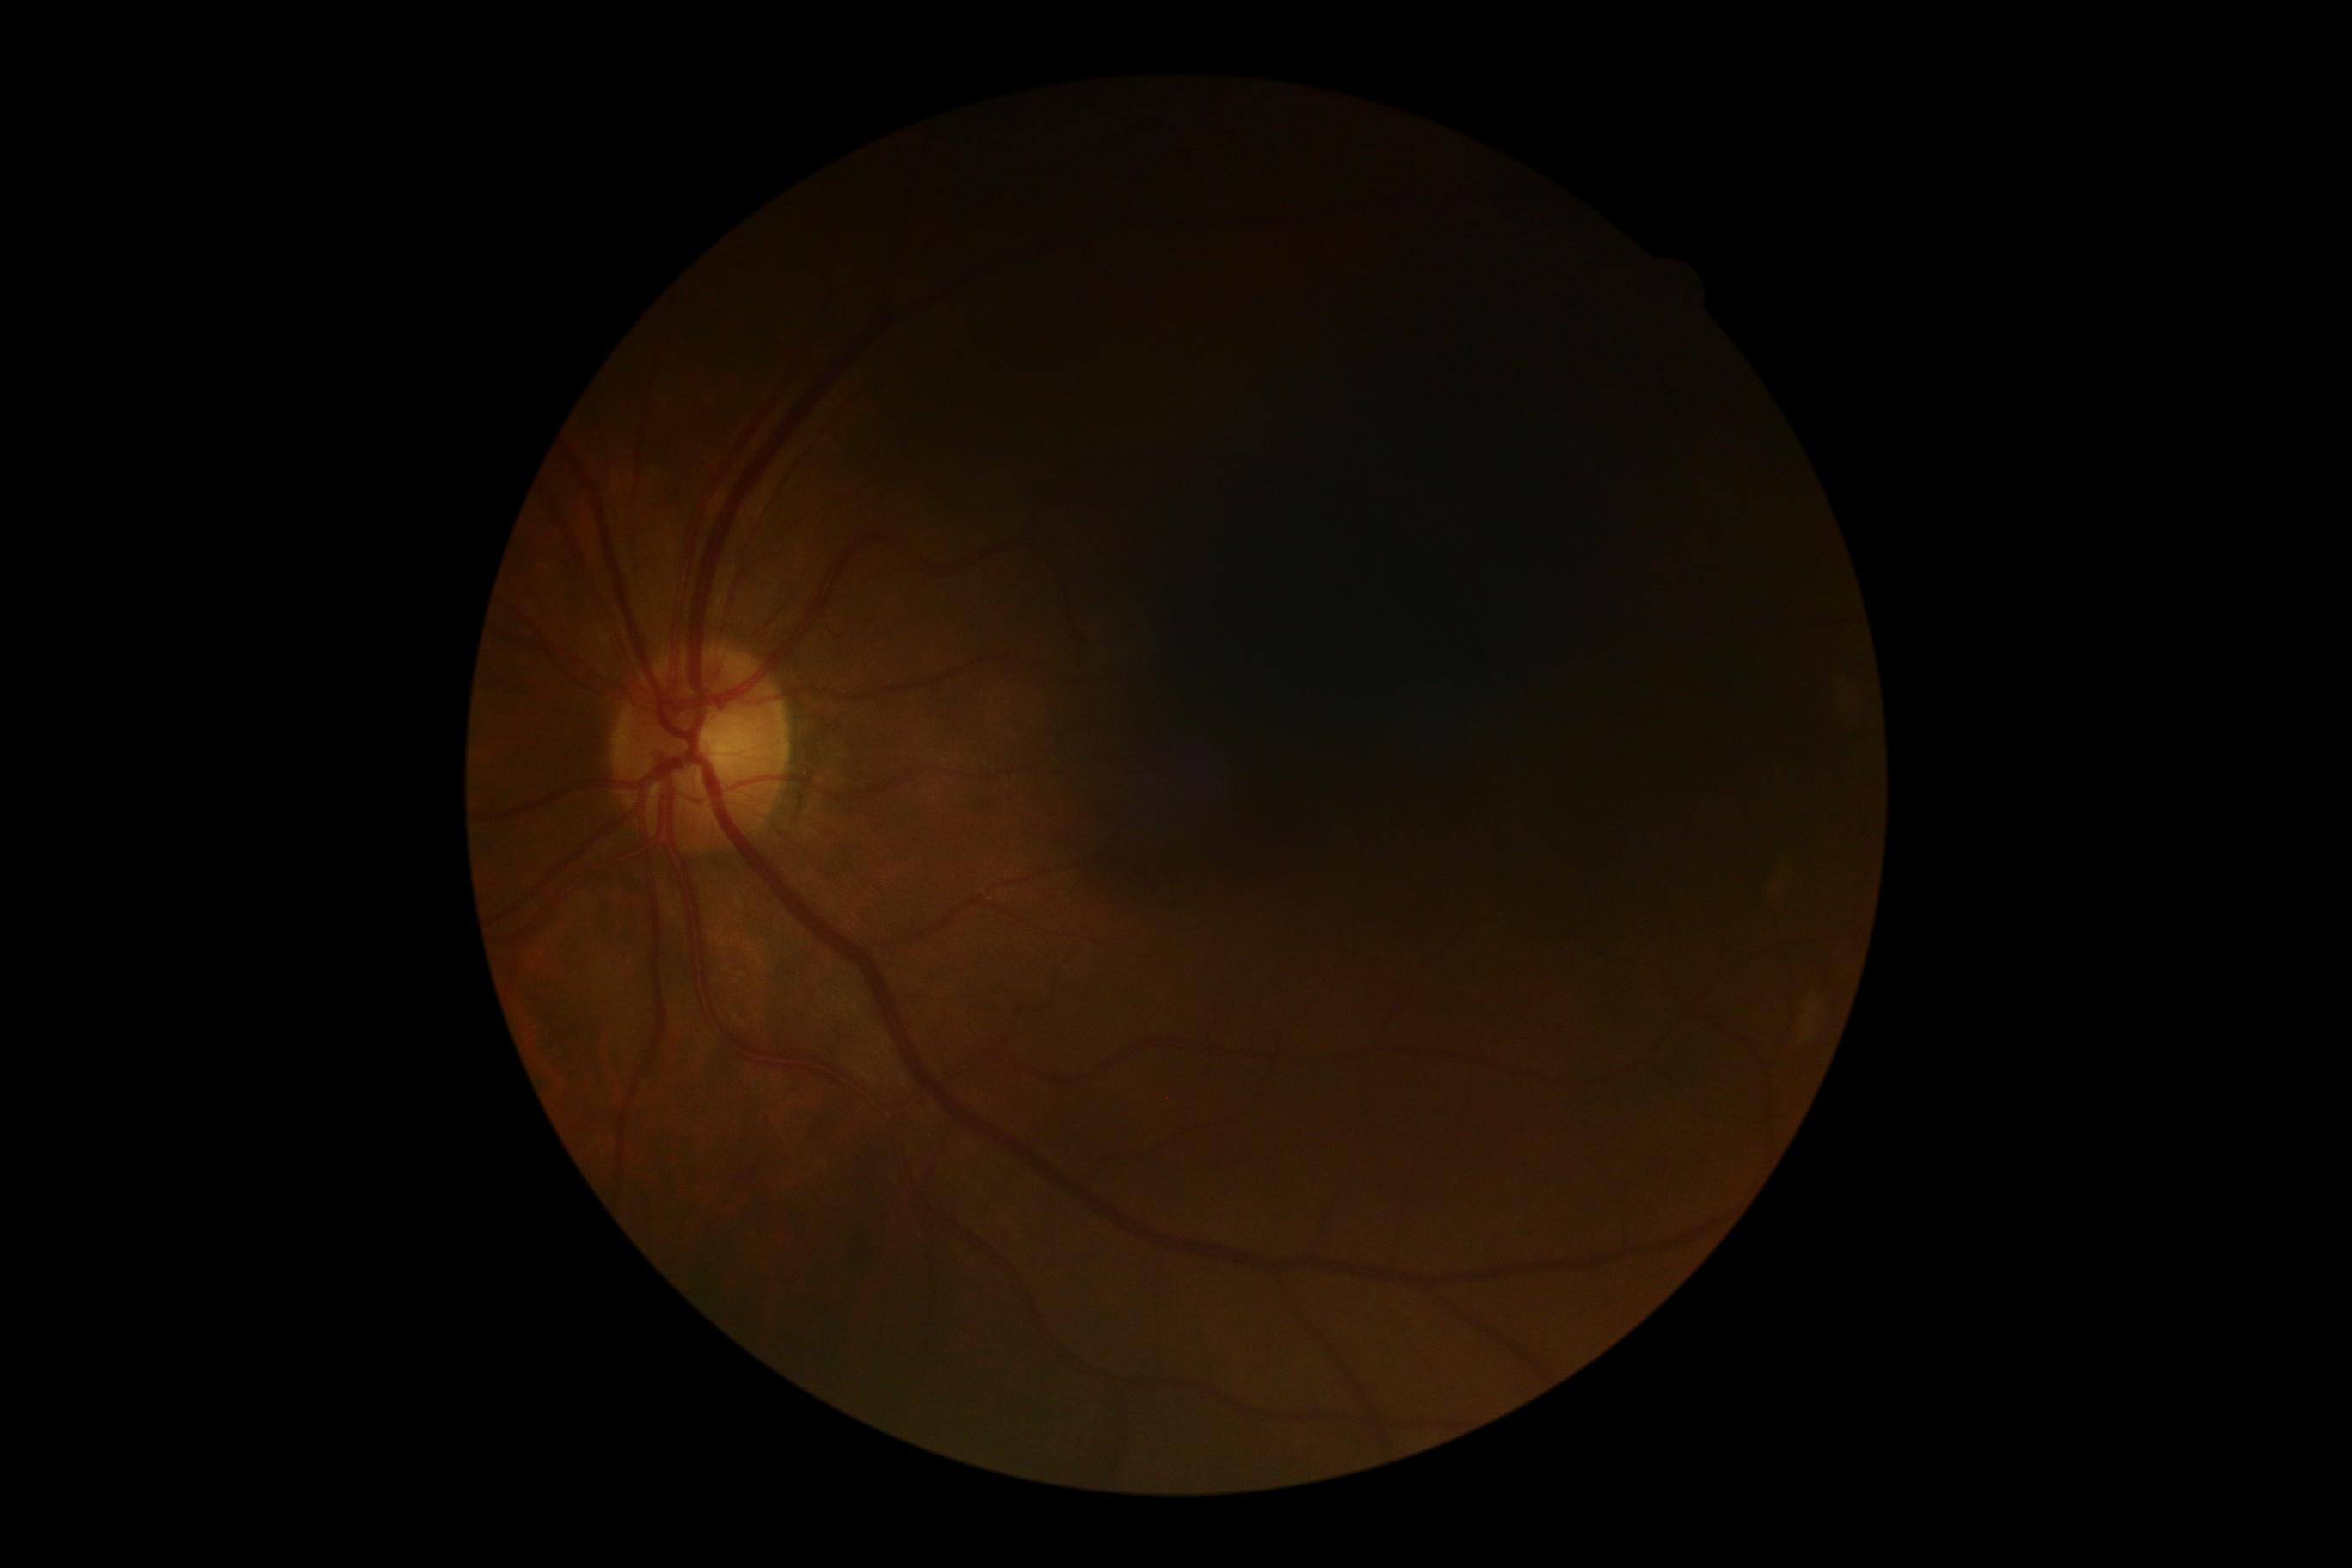

DR stage: no apparent diabetic retinopathy (grade 0).